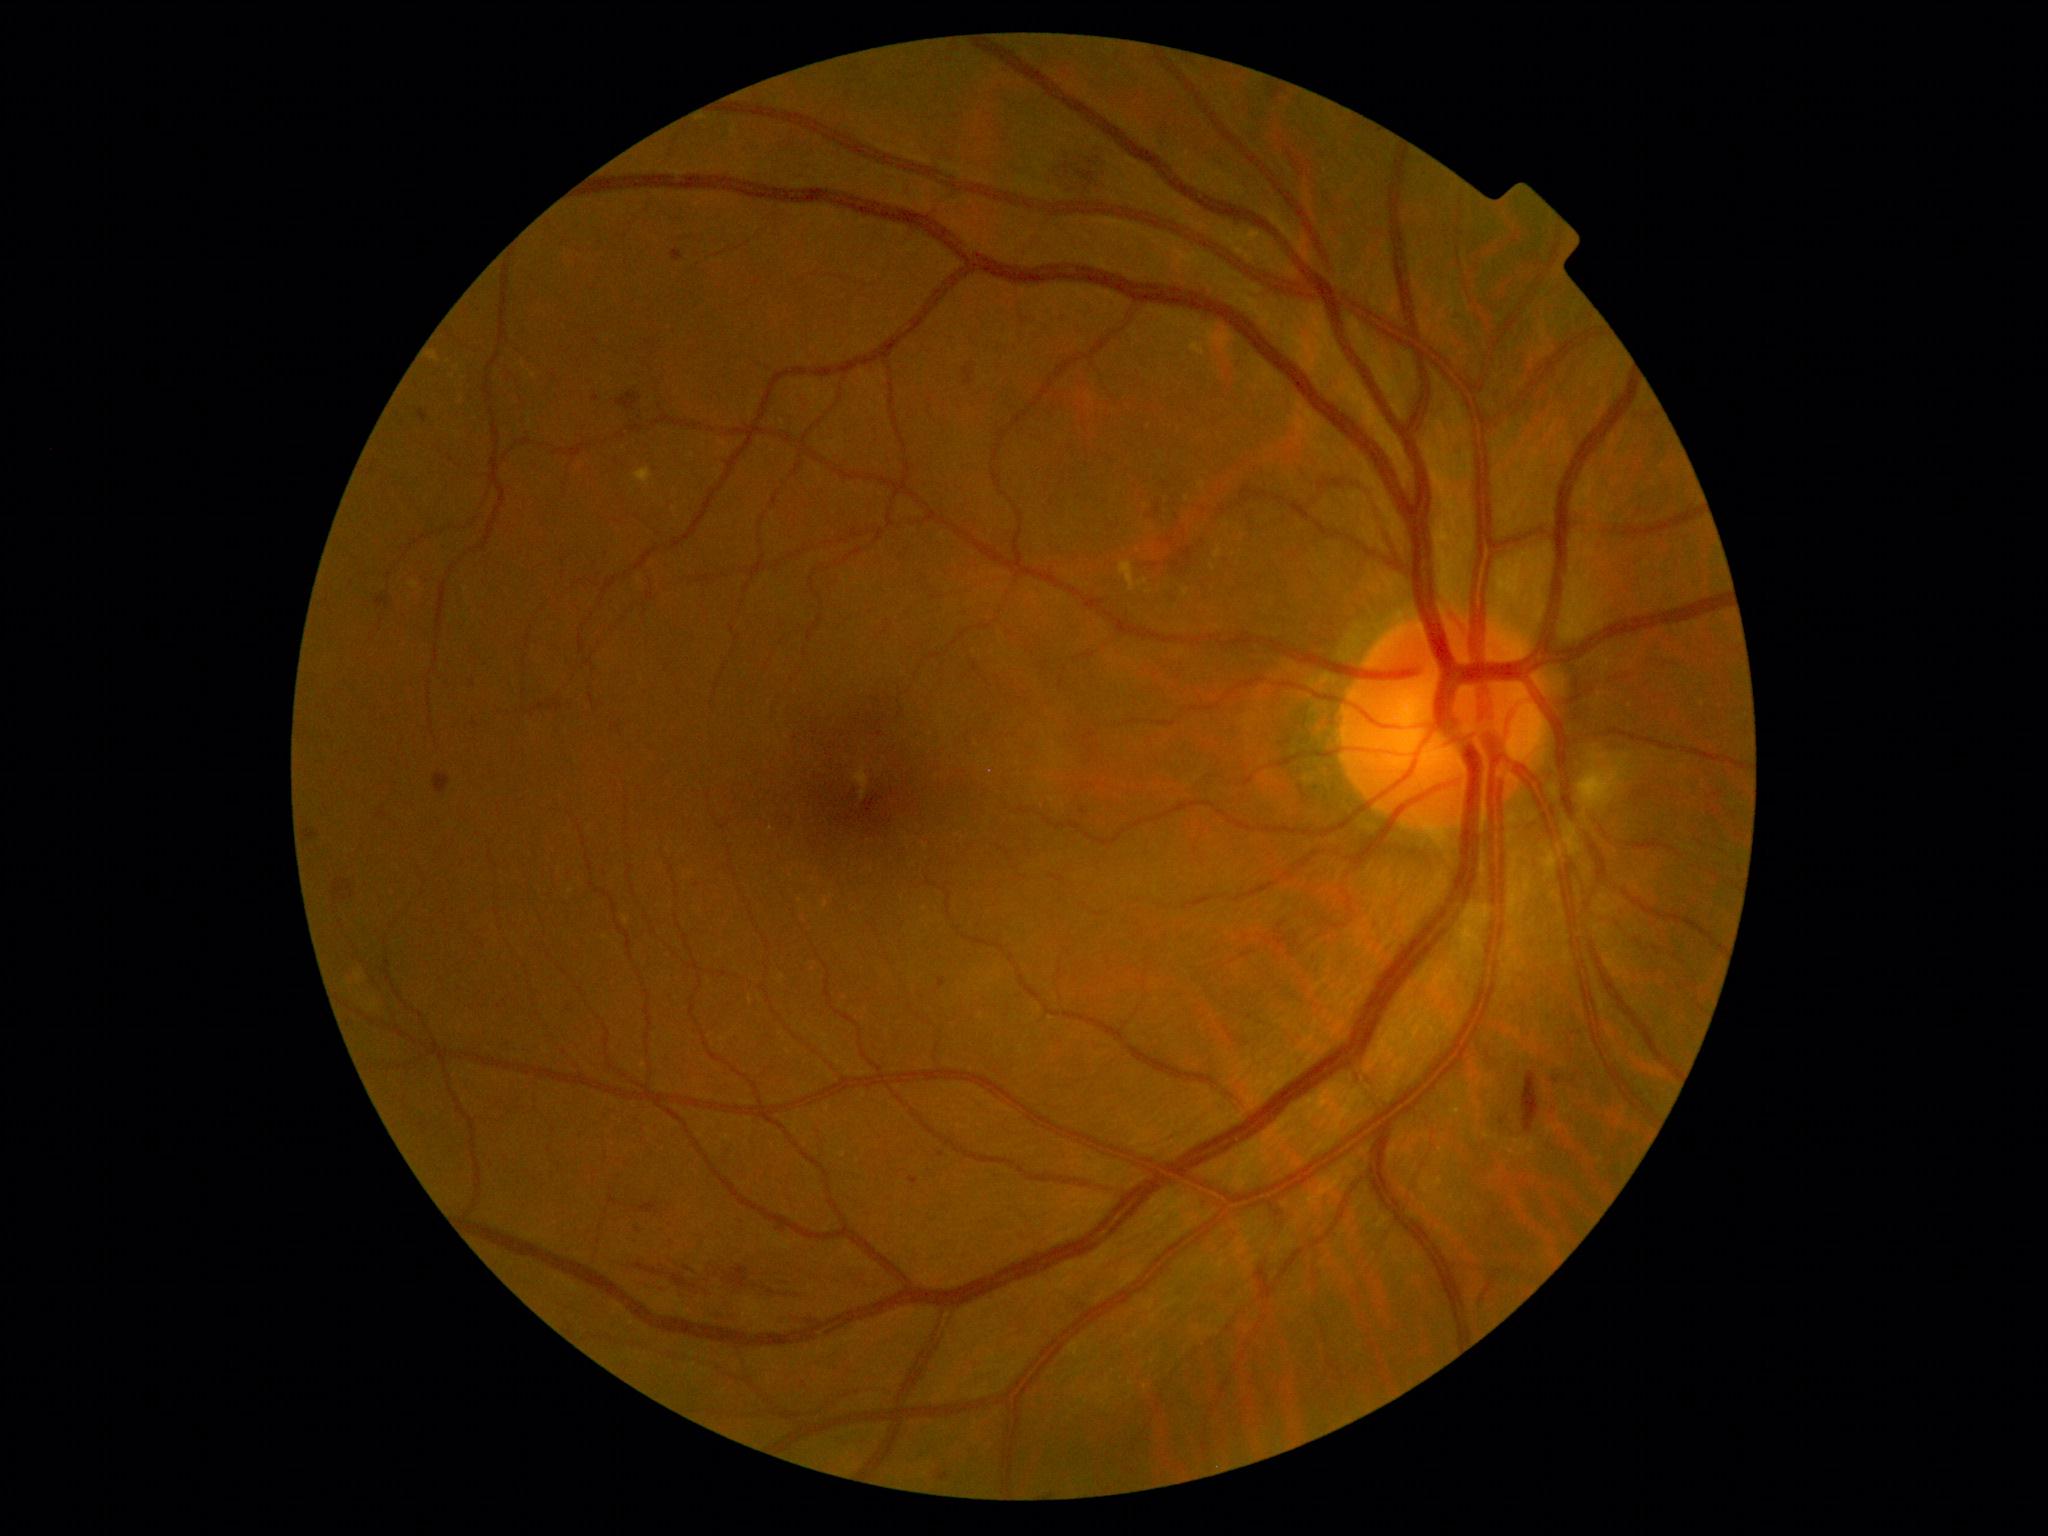
Diabetic retinopathy (DR): grade 2 (moderate NPDR). Hard exudates (EXs) located at (429, 351, 439, 362), (1191, 341, 1205, 356), (1120, 561, 1148, 591), (635, 468, 653, 487), (1182, 589, 1189, 597), (1214, 546, 1224, 560). Additional small EXs near pt(1213, 568), pt(1202, 486), pt(1187, 499). No soft exudates (SEs) identified. Hemorrhages (HEs) located at (303, 830, 318, 839), (672, 1274, 688, 1287), (618, 392, 642, 411), (333, 879, 355, 901), (641, 1203, 658, 1214), (635, 1263, 666, 1276), (721, 1267, 800, 1299), (681, 1267, 699, 1274), (376, 597, 390, 607), (964, 368, 974, 385), (1523, 1072, 1540, 1133), (434, 773, 450, 793), (1078, 155, 1106, 191). Microaneurysms (MAs) include those at (908, 1177, 918, 1185), (939, 978, 946, 988), (419, 410, 429, 422), (672, 249, 684, 262), (937, 1469, 950, 1482). Additional small MAs near pt(1556, 1080), pt(941, 1155), pt(1084, 812), pt(595, 398), pt(638, 1231).